Nonmydriatic.
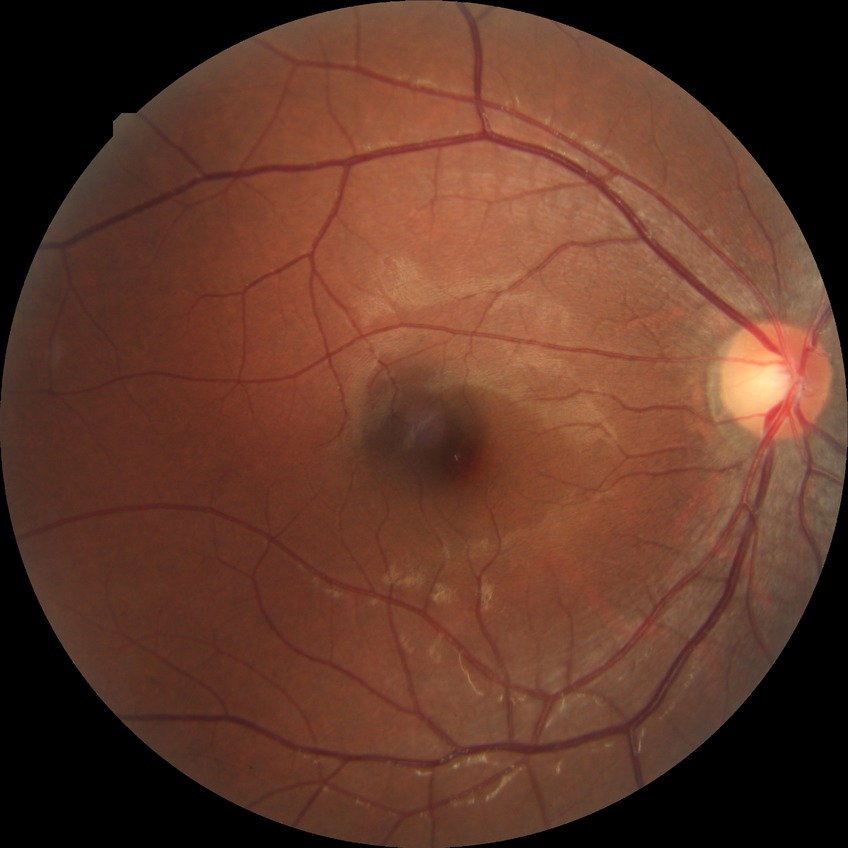 Diabetic retinopathy (DR): no diabetic retinopathy (NDR).